1932 x 1932 pixels: 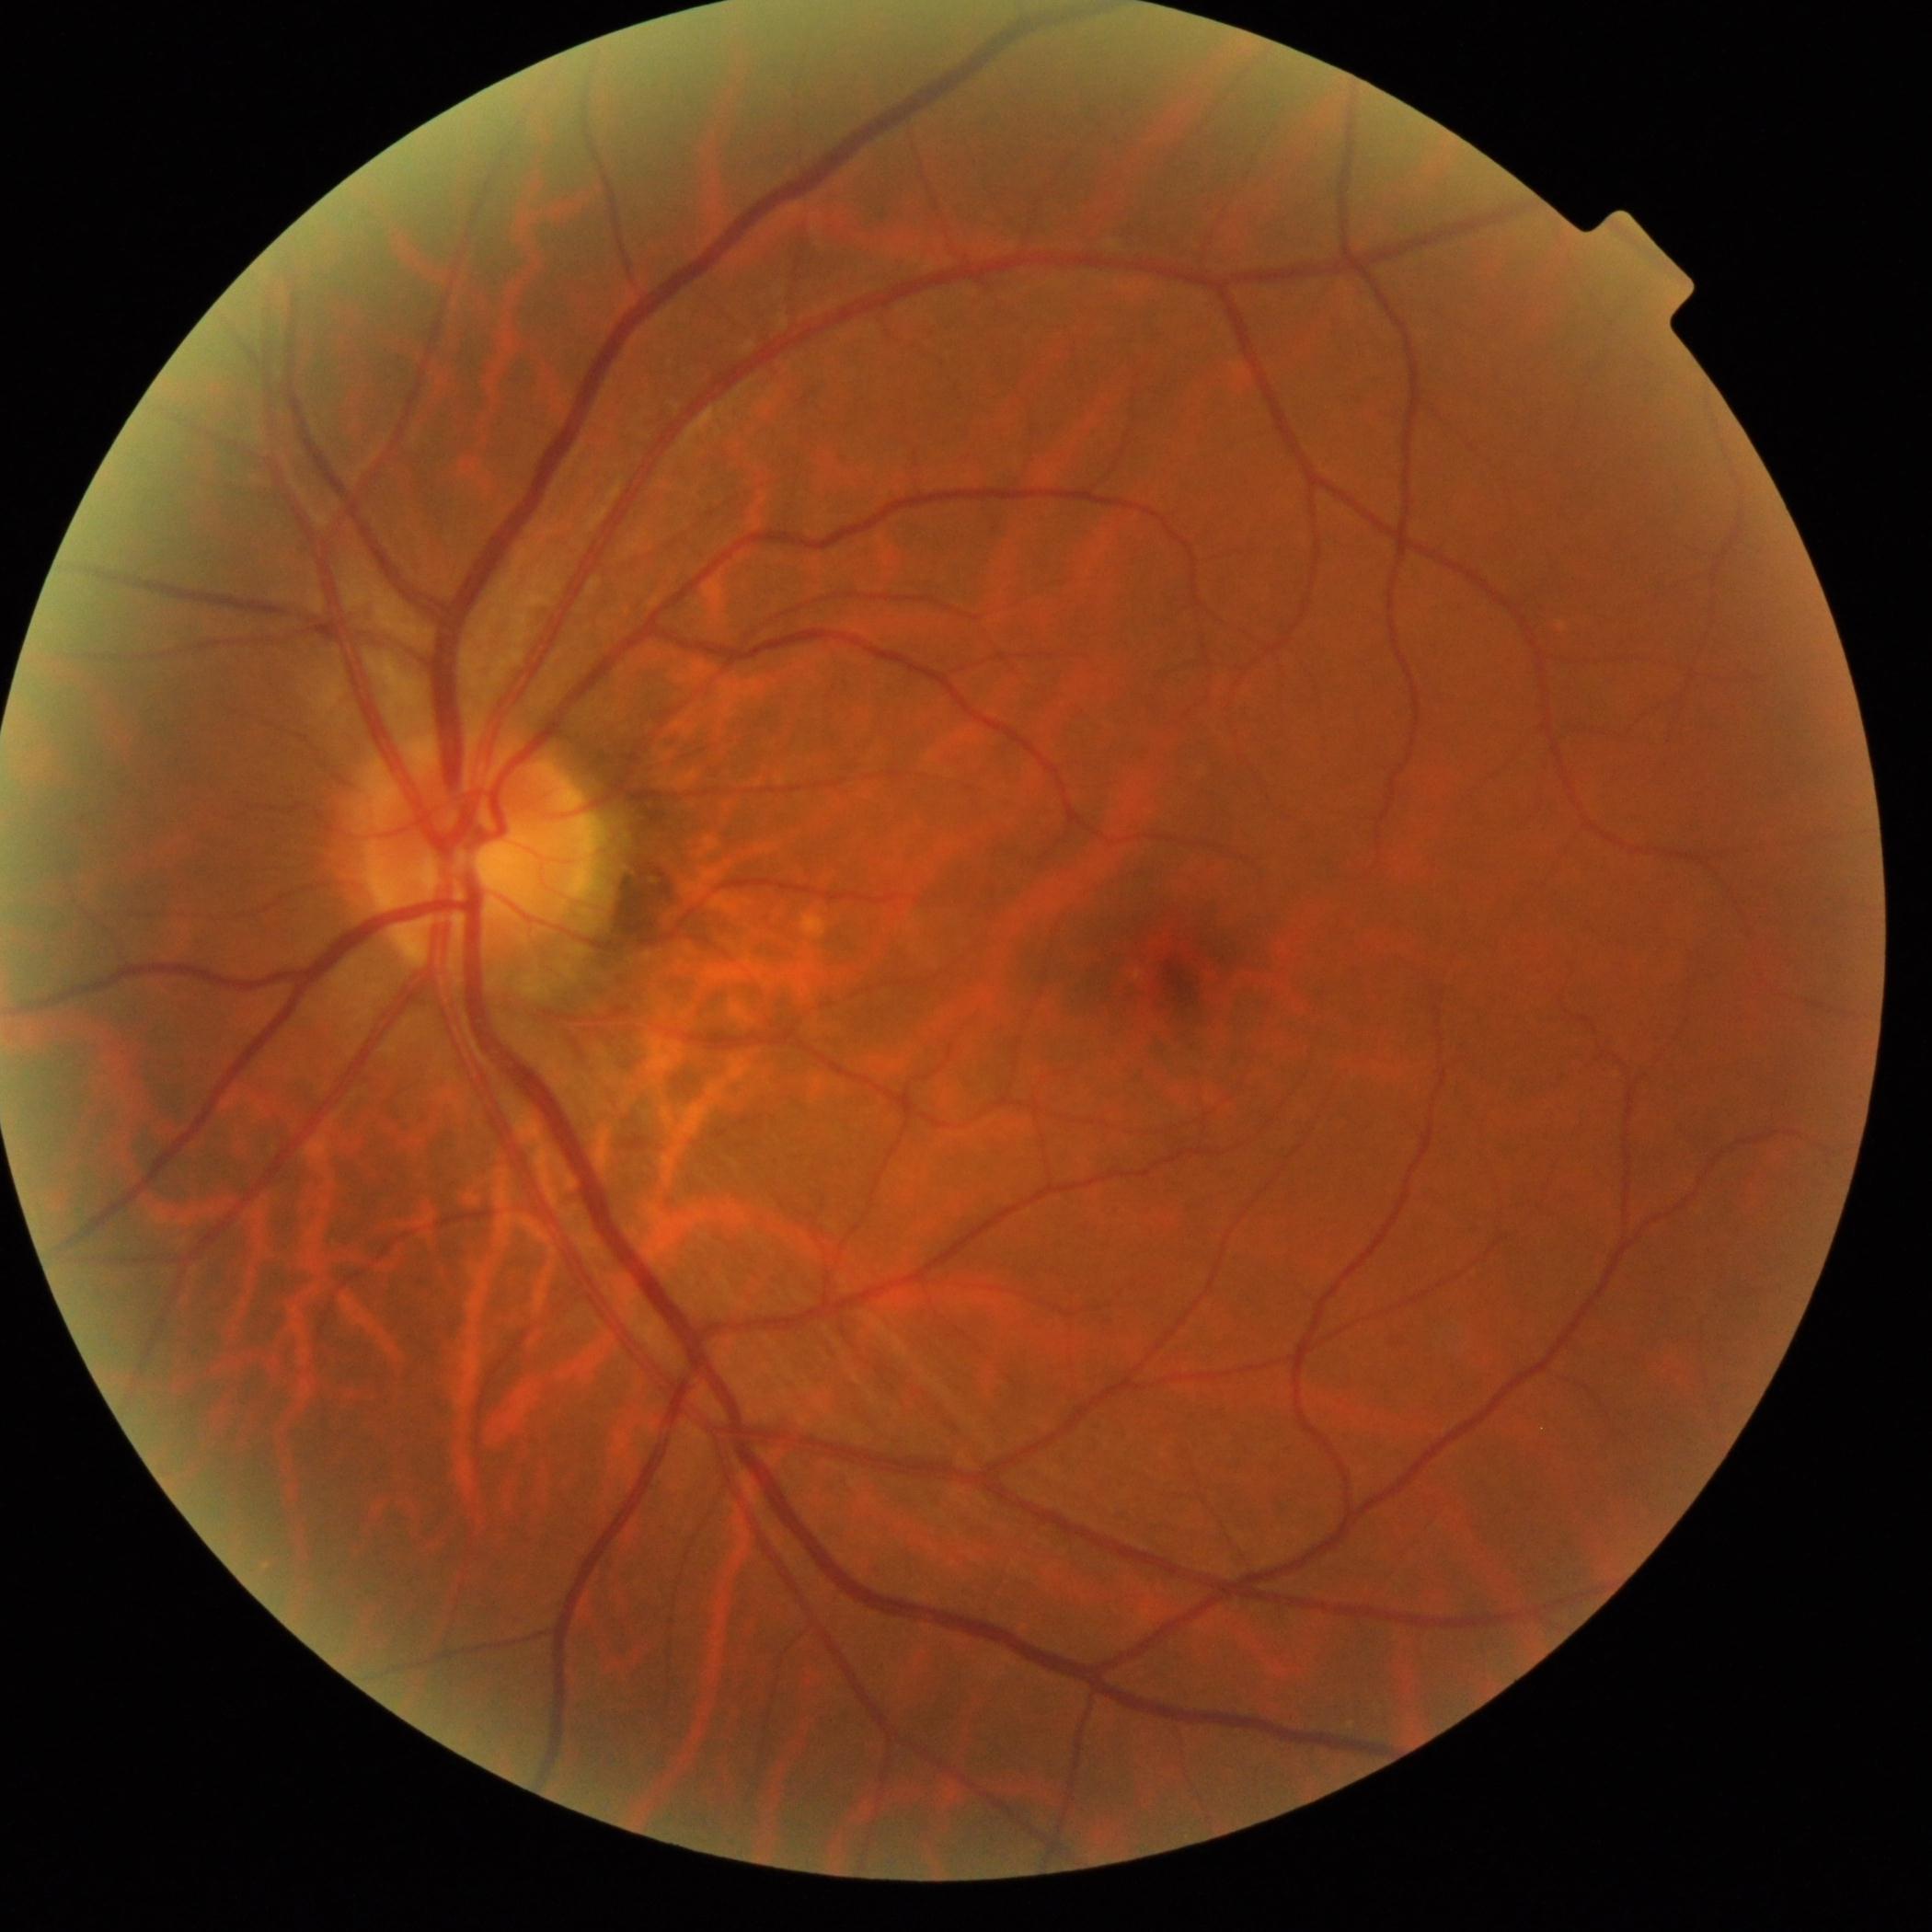

DR stage is grade 0 — no visible signs of diabetic retinopathy.